Davis DR grading:
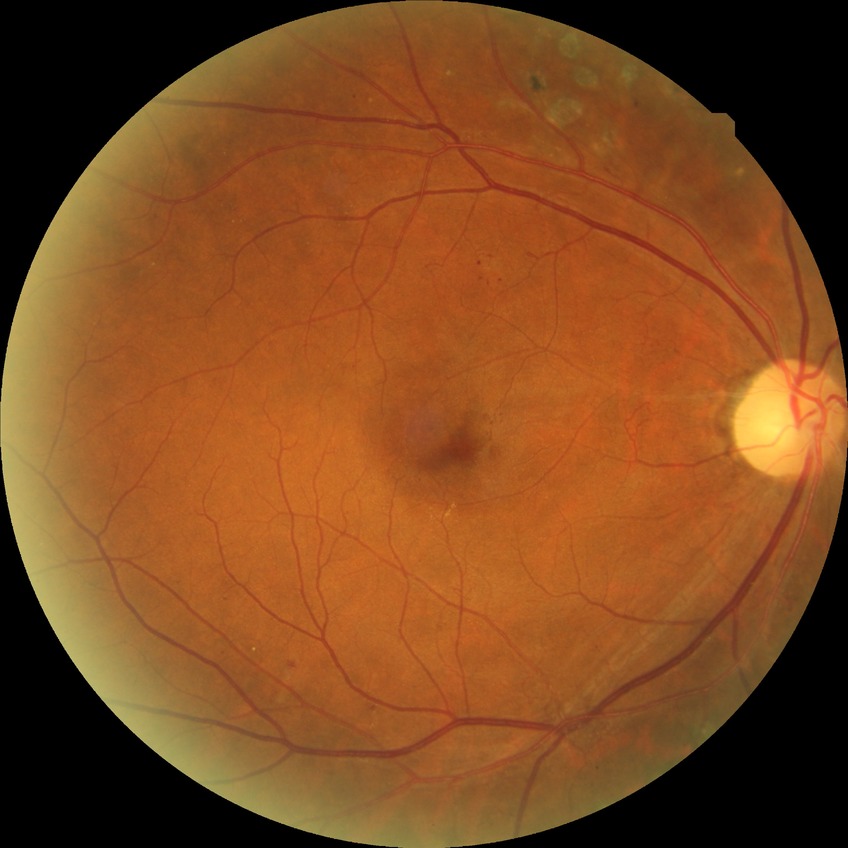

Modified Davis classification: proliferative diabetic retinopathy.